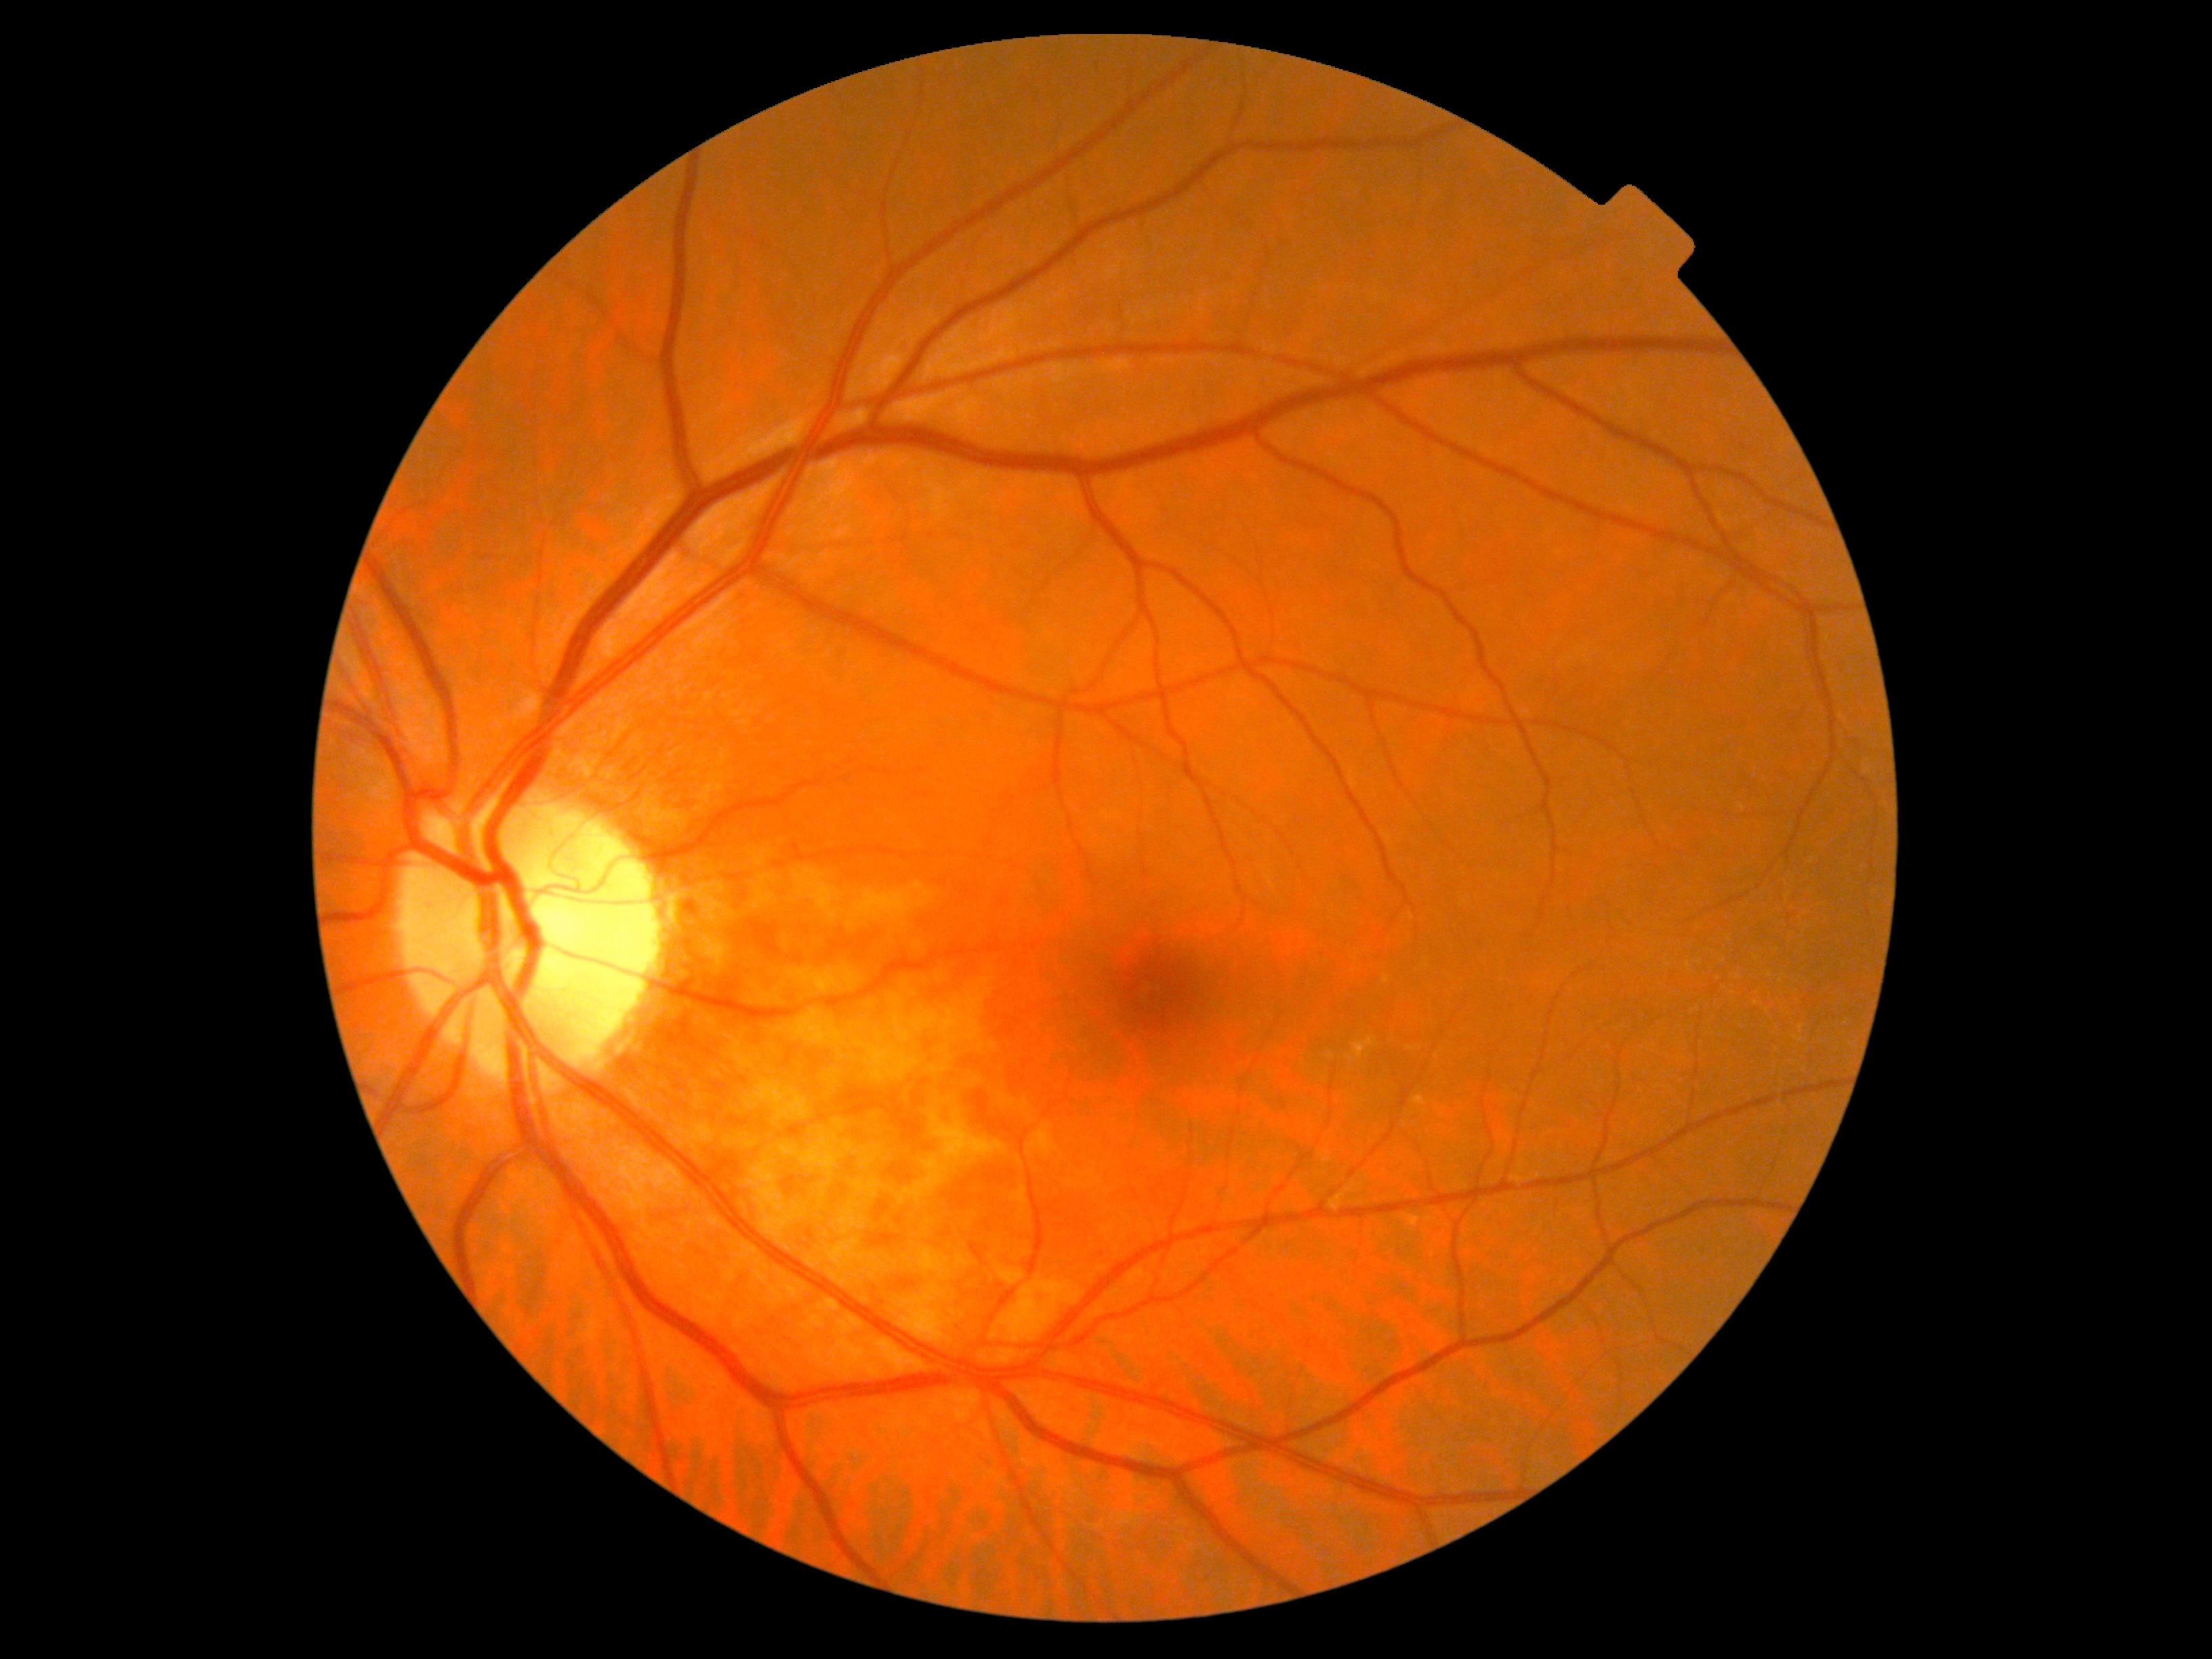
DR: 0/4.